CFP
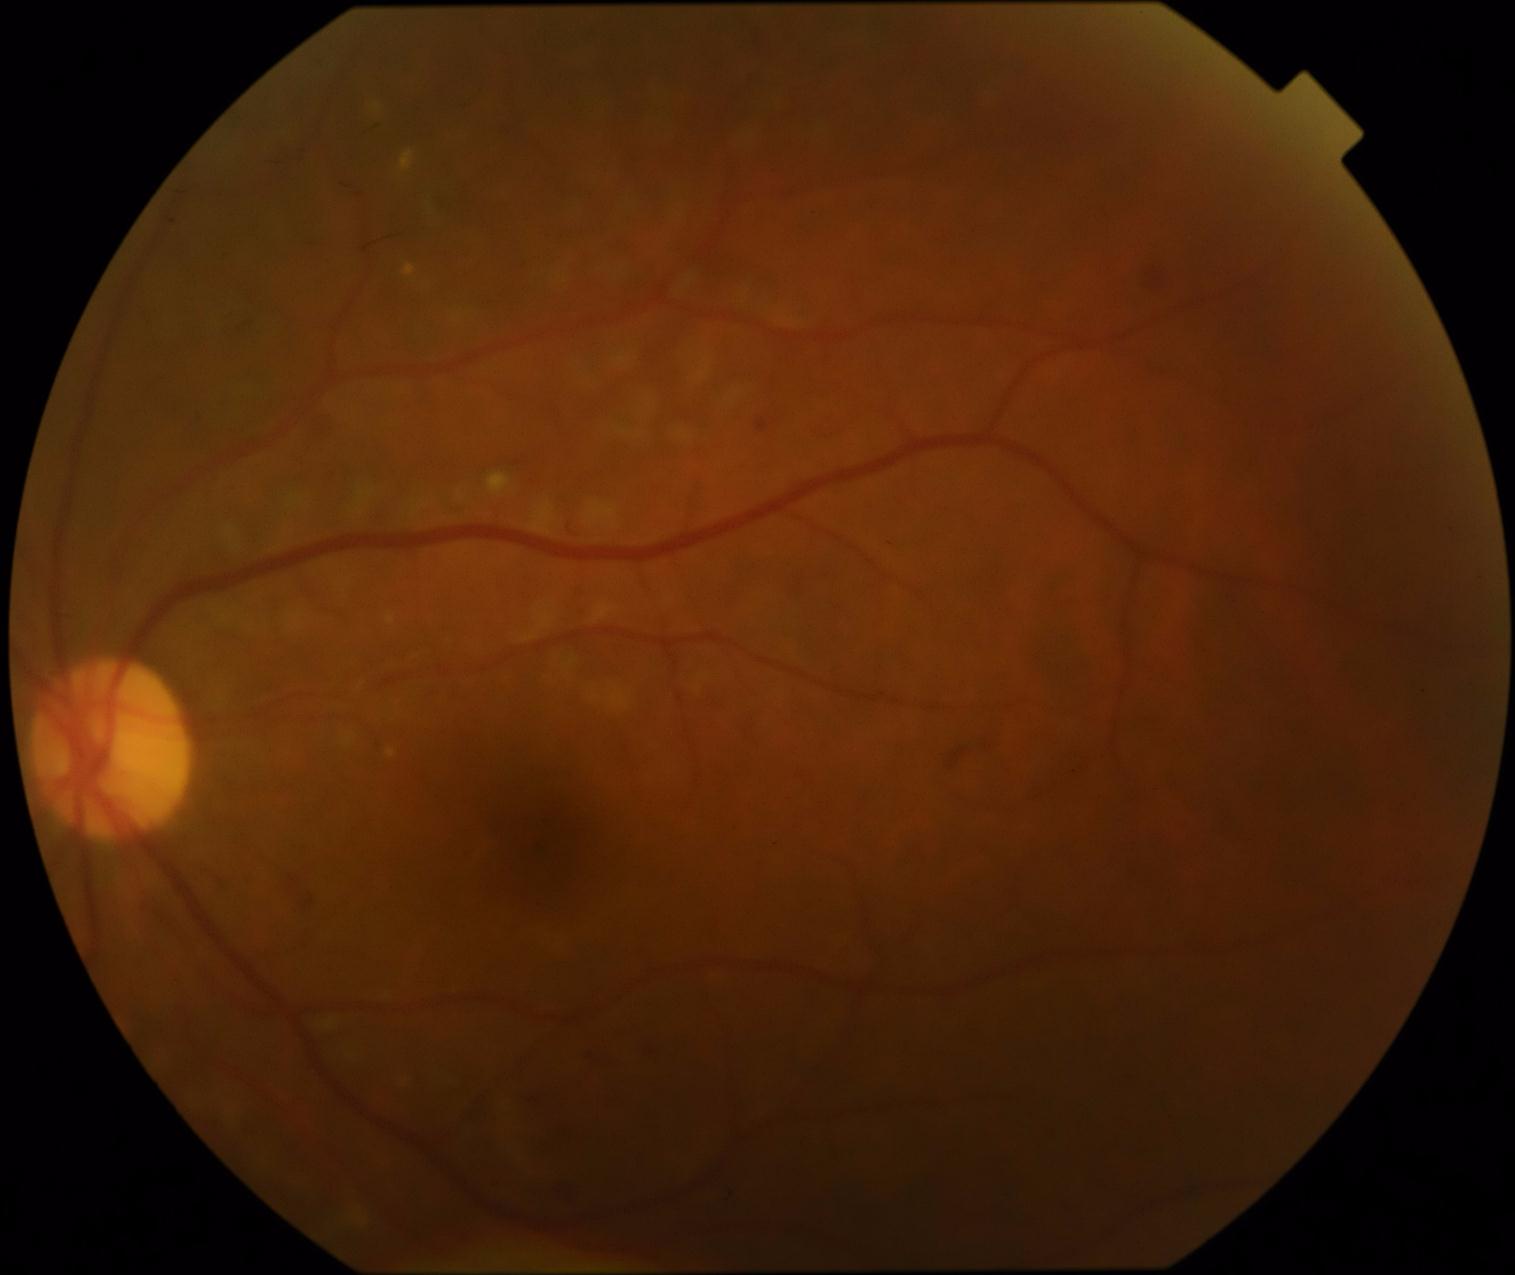
{"dr_grade": "2/4", "dr_category": "non-proliferative diabetic retinopathy"}